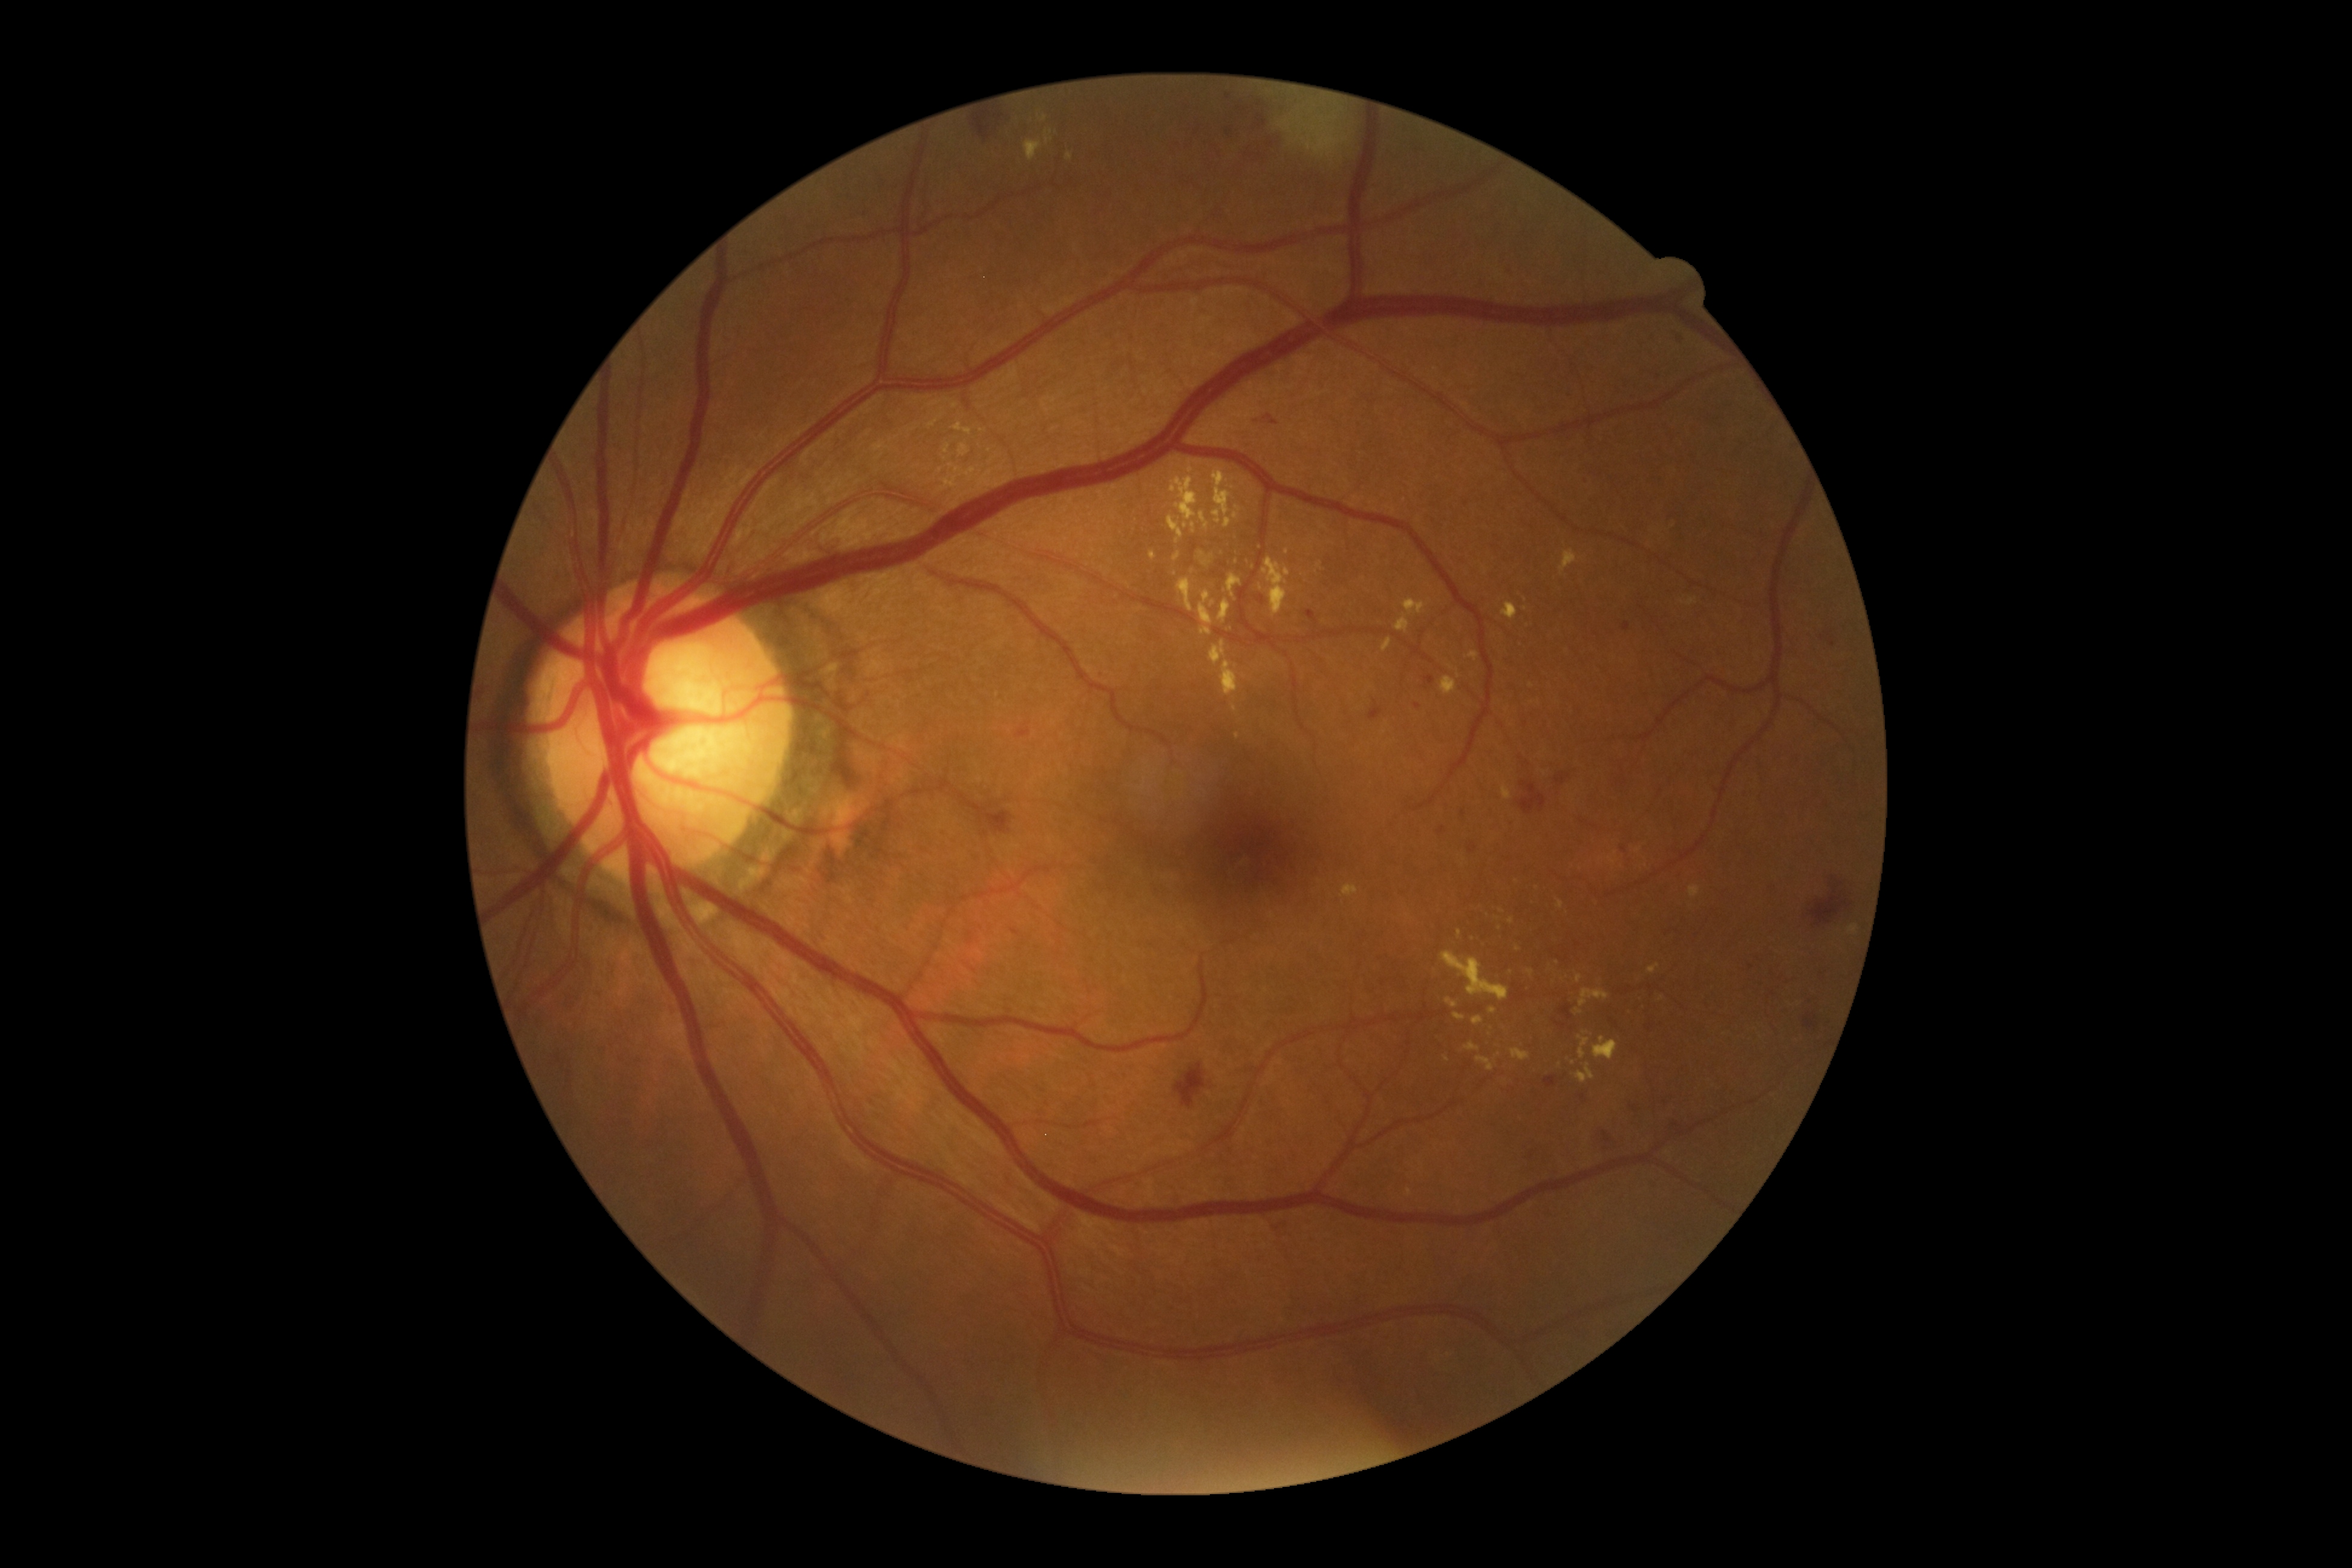
Retinopathy grade is 2
Representative lesions:
hard exudates (continued): <region>1168, 515, 1184, 544</region> | <region>1382, 638, 1392, 652</region> | <region>1067, 152, 1074, 160</region> | <region>1263, 557, 1290, 616</region> | <region>953, 422, 972, 436</region> | <region>1233, 512, 1238, 520</region> | <region>1577, 1035, 1590, 1059</region> | <region>1174, 551, 1180, 561</region> | <region>1221, 660, 1238, 696</region> | <region>1469, 652, 1479, 660</region> | <region>1502, 785, 1512, 800</region>
Small hard exudates near 1682:602 | 1498:1055 | 1511:921 | 1499:928 | 1261:587